Modified Davis classification
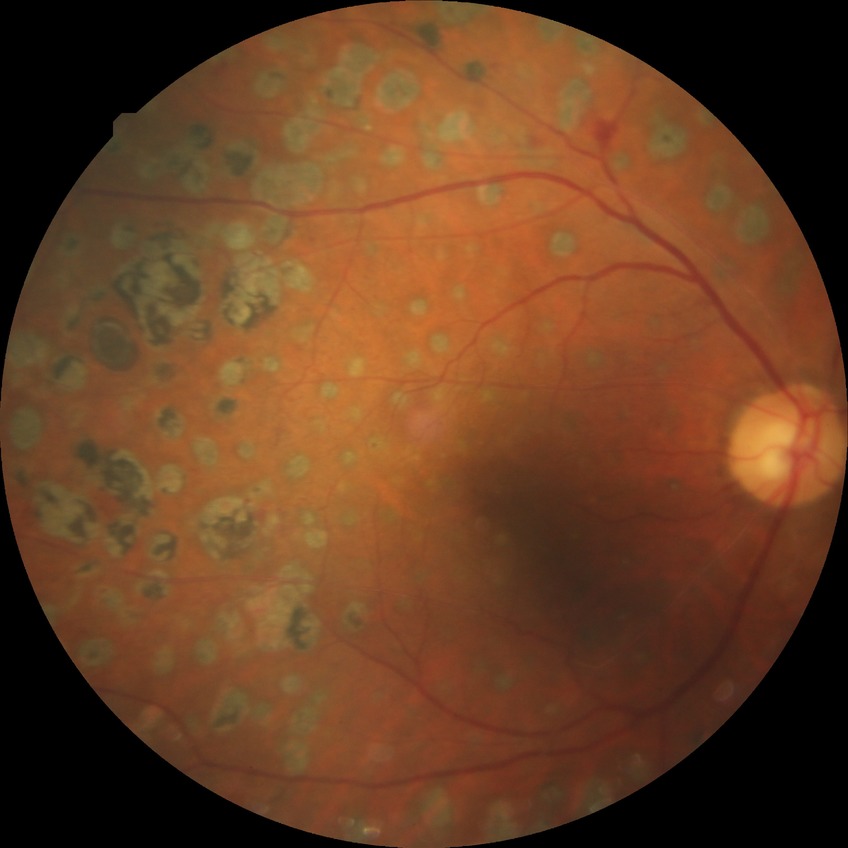

Diabetic retinopathy (DR) is proliferative diabetic retinopathy (PDR).